2352x1568; FOV: 45 degrees; retinal fundus photograph.
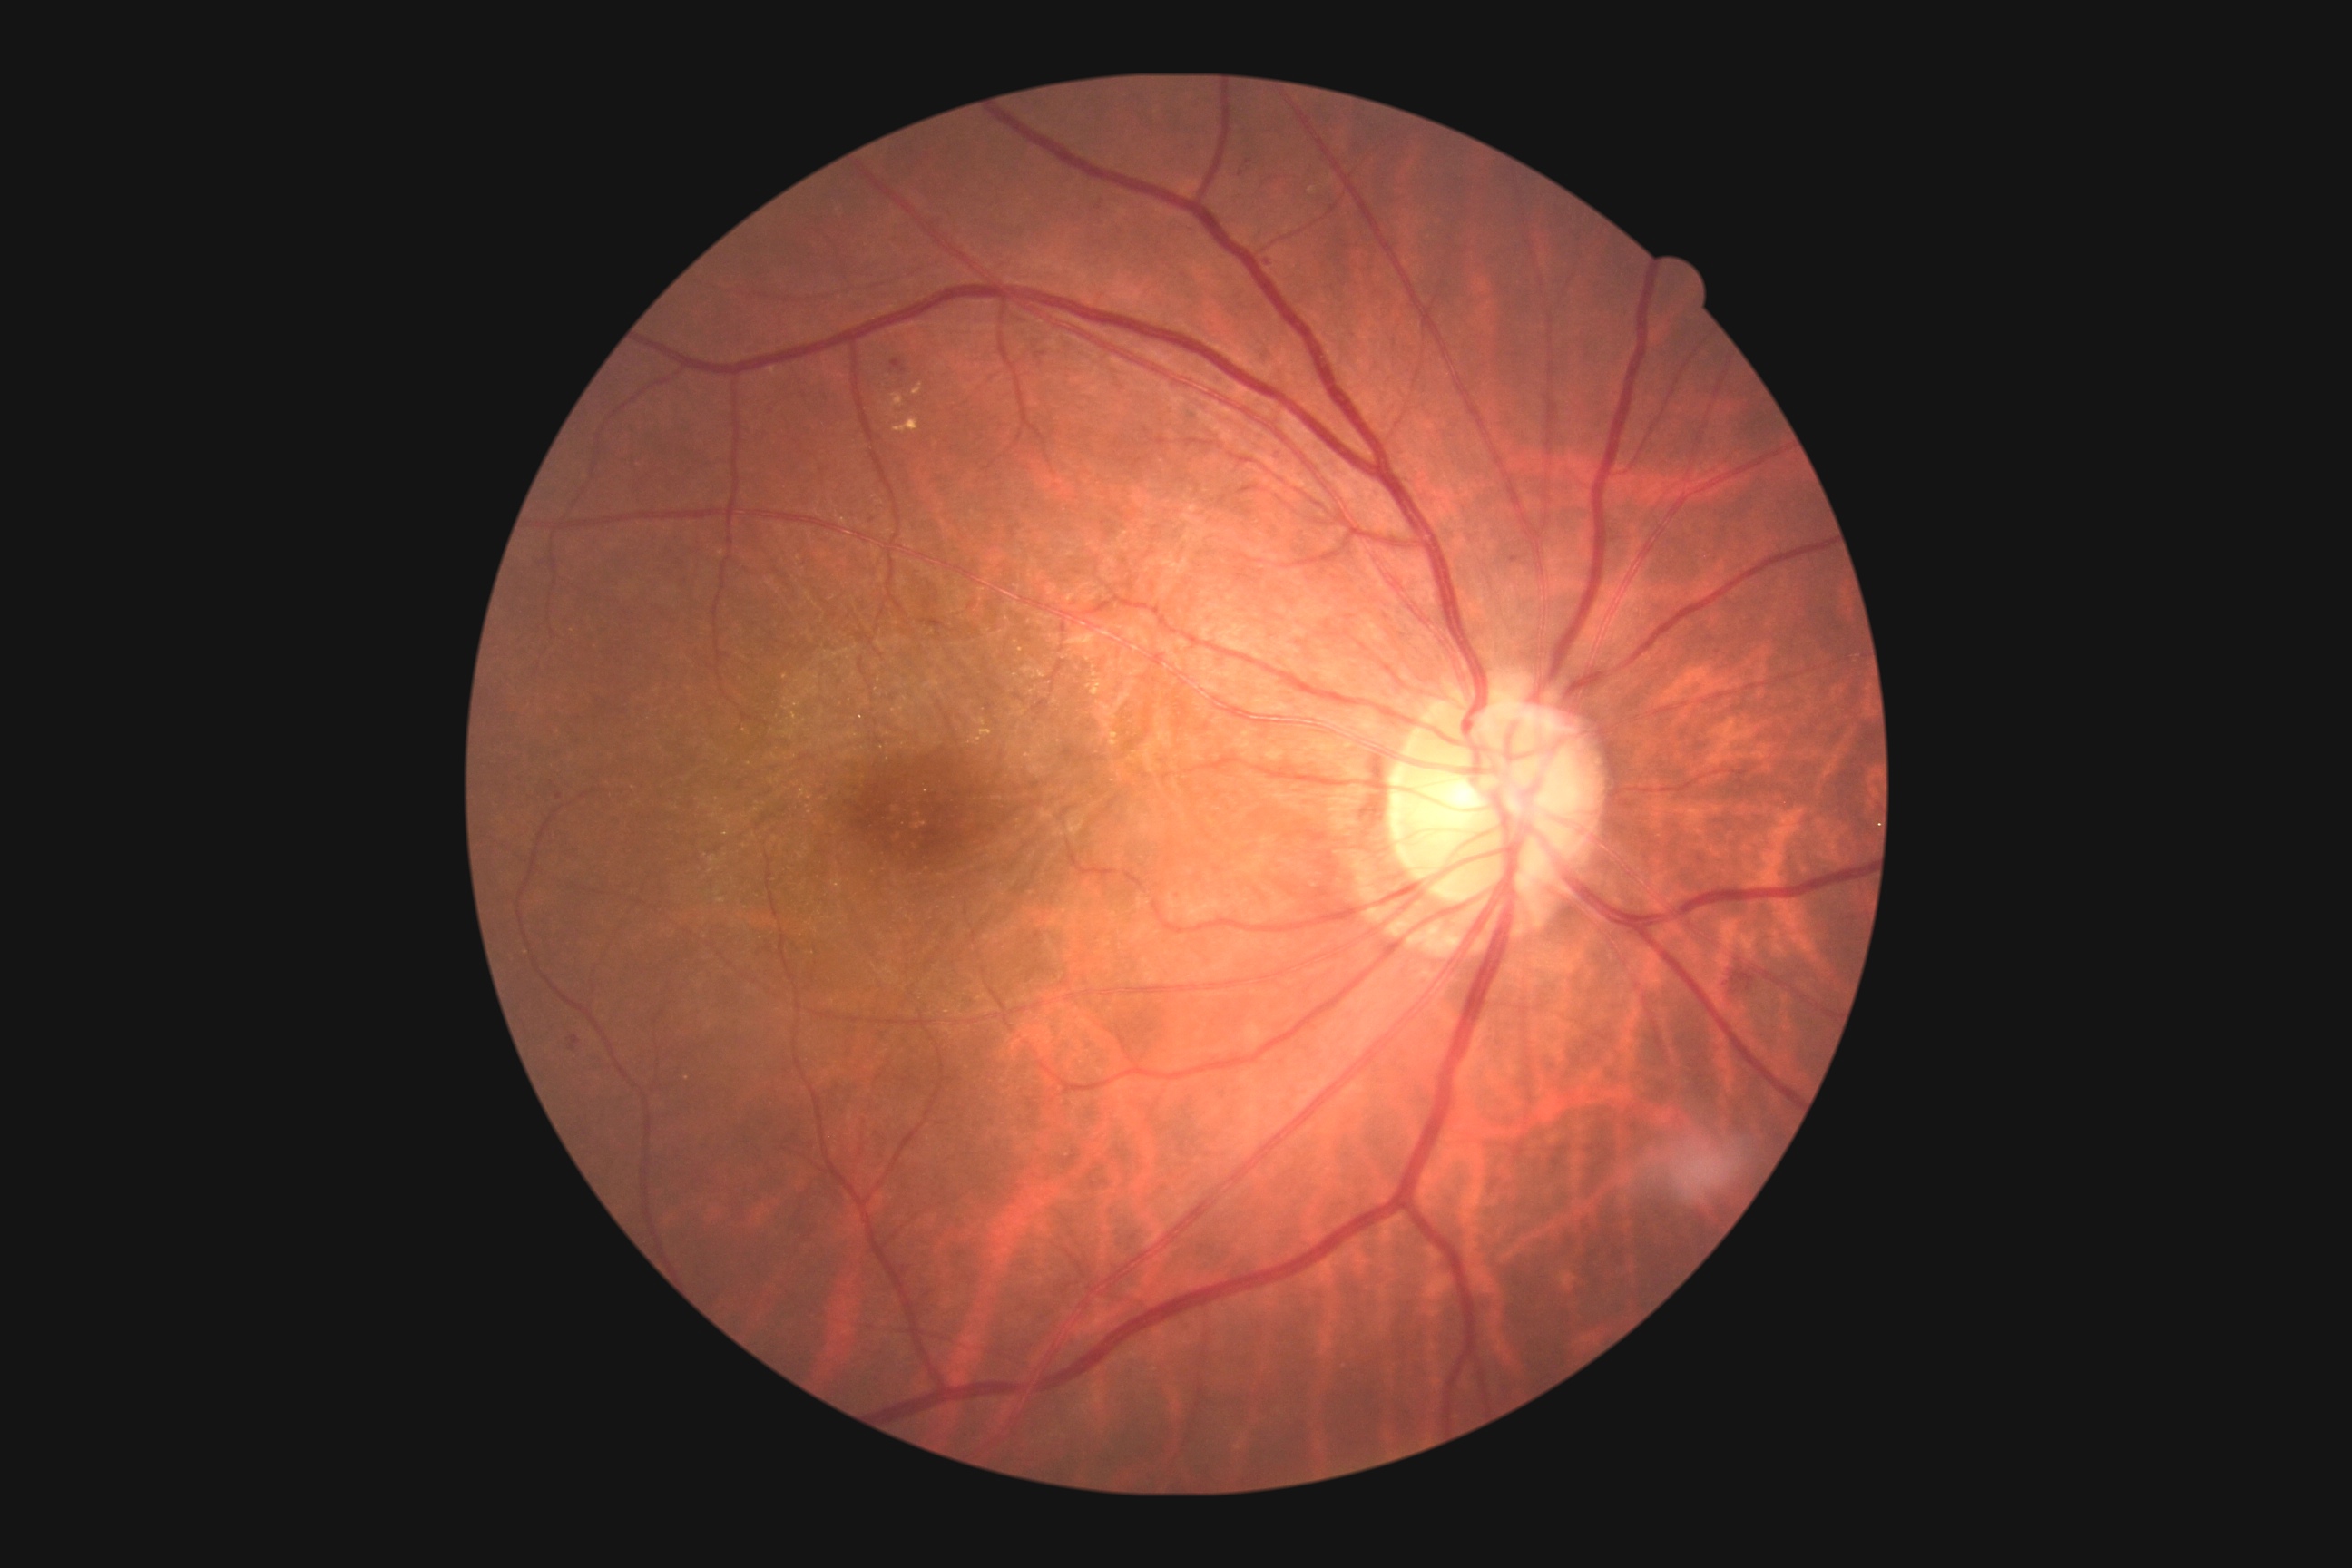
Retinopathy grade is 2.